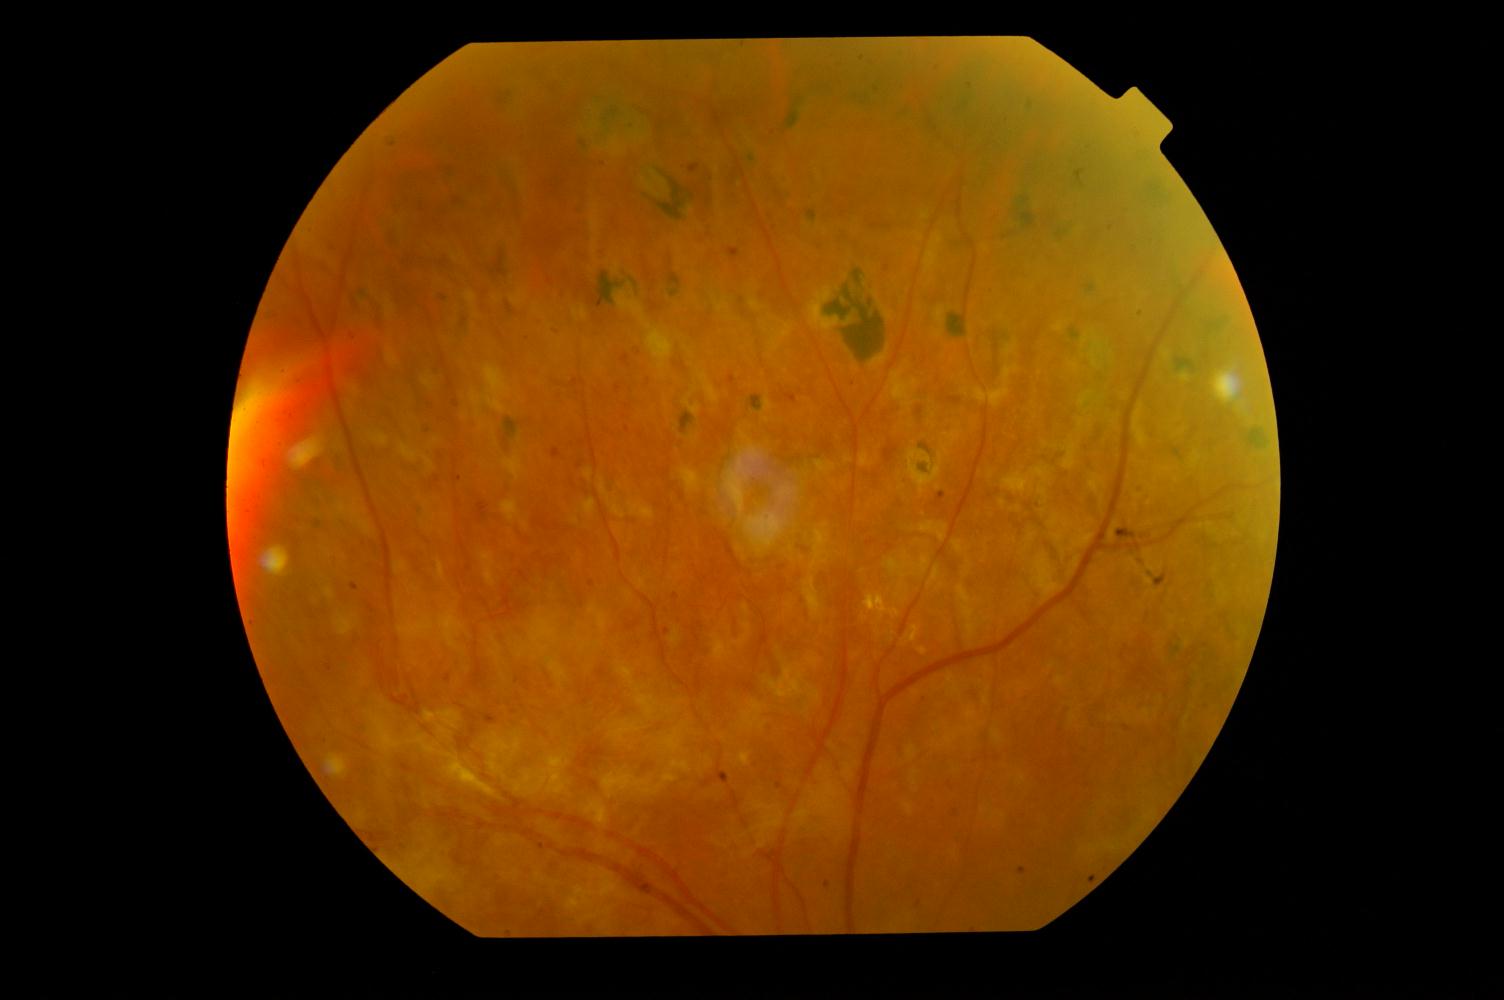

Findings consistent with diabetic retinopathy.